Color fundus image: 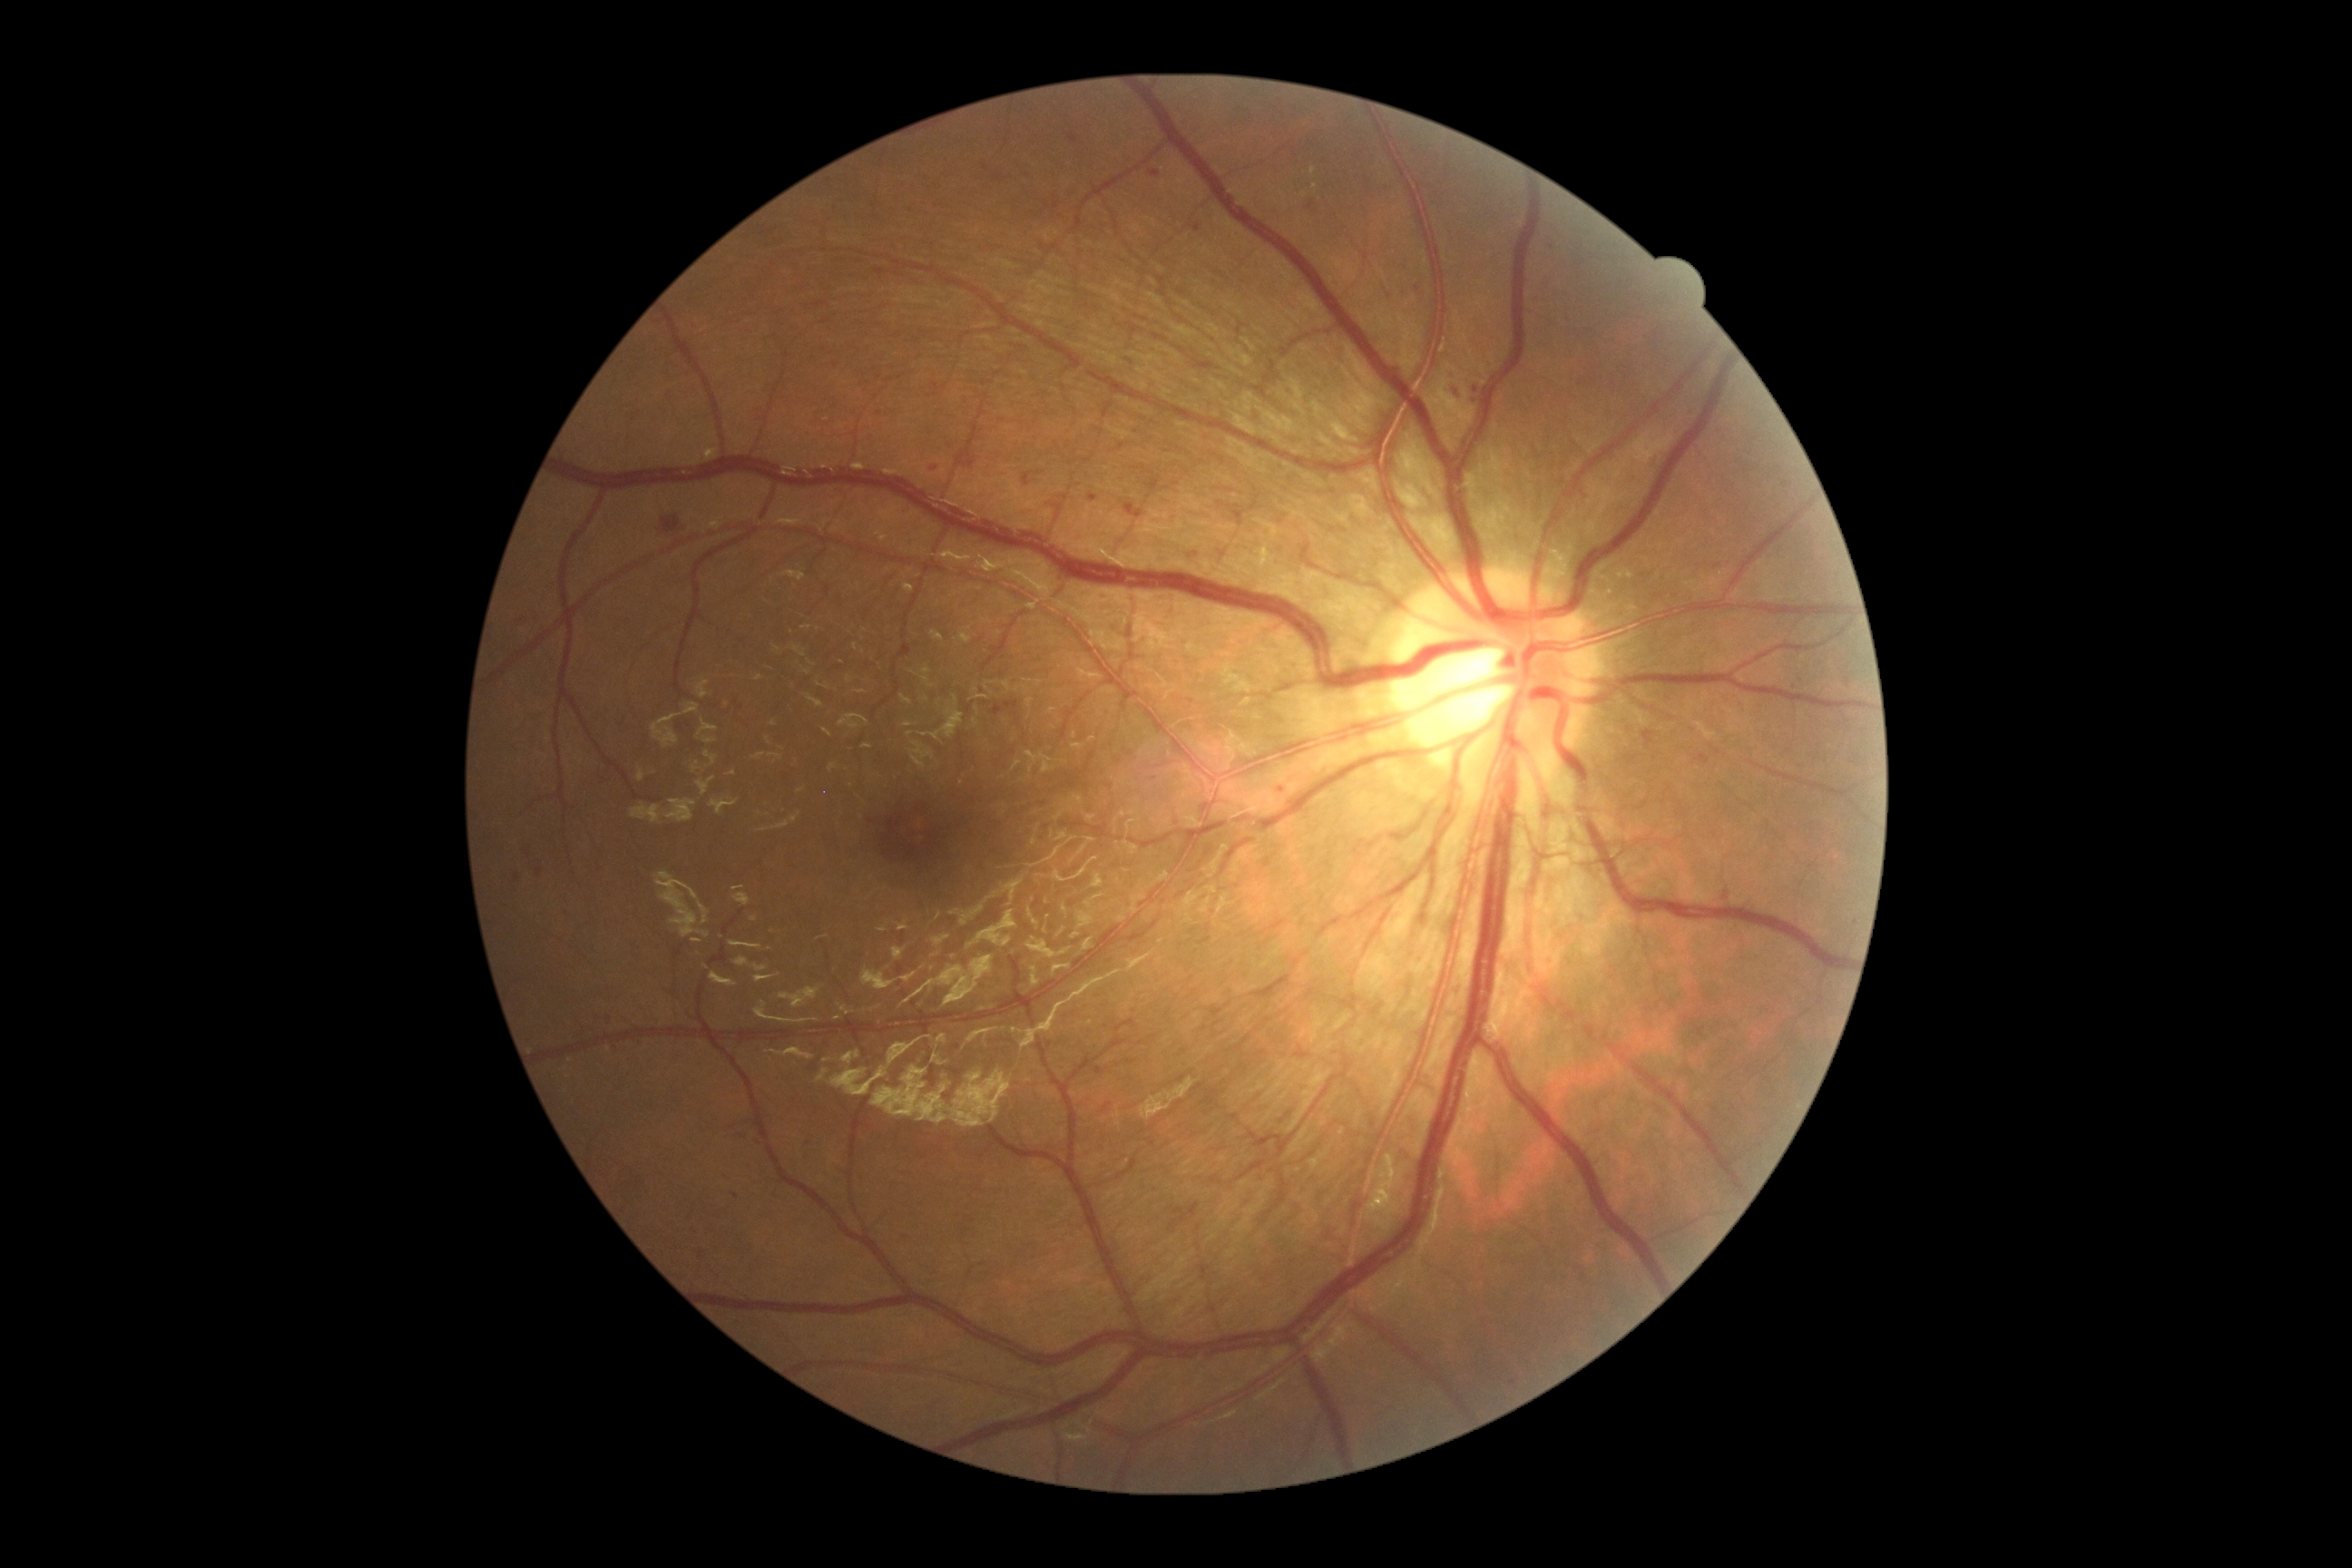

Diabetic retinopathy grade: 2 (moderate NPDR)
Selected lesions:
hemorrhages (continued) = (x1=658, y1=514, x2=687, y2=536) | (x1=956, y1=447, x2=979, y2=469) | (x1=1306, y1=201, x2=1318, y2=215) | (x1=930, y1=466, x2=939, y2=473) | (x1=1066, y1=132, x2=1083, y2=144) | (x1=1124, y1=504, x2=1144, y2=520)
soft exudates = none identified
hard exudates = none identified
microaneurysms (continued) = (x1=1023, y1=473, x2=1032, y2=485) | (x1=1694, y1=754, x2=1710, y2=765) | (x1=1473, y1=387, x2=1480, y2=395) | (x1=1473, y1=400, x2=1482, y2=404) | (x1=524, y1=847, x2=531, y2=859) | (x1=1449, y1=369, x2=1462, y2=380) | (x1=1642, y1=730, x2=1658, y2=750) | (x1=1792, y1=674, x2=1807, y2=691) | (x1=1088, y1=495, x2=1099, y2=502) | (x1=1402, y1=293, x2=1411, y2=299) | (x1=1714, y1=564, x2=1723, y2=571) | (x1=990, y1=700, x2=1019, y2=718) | (x1=1453, y1=386, x2=1467, y2=400)
Smaller microaneurysms around 825:840